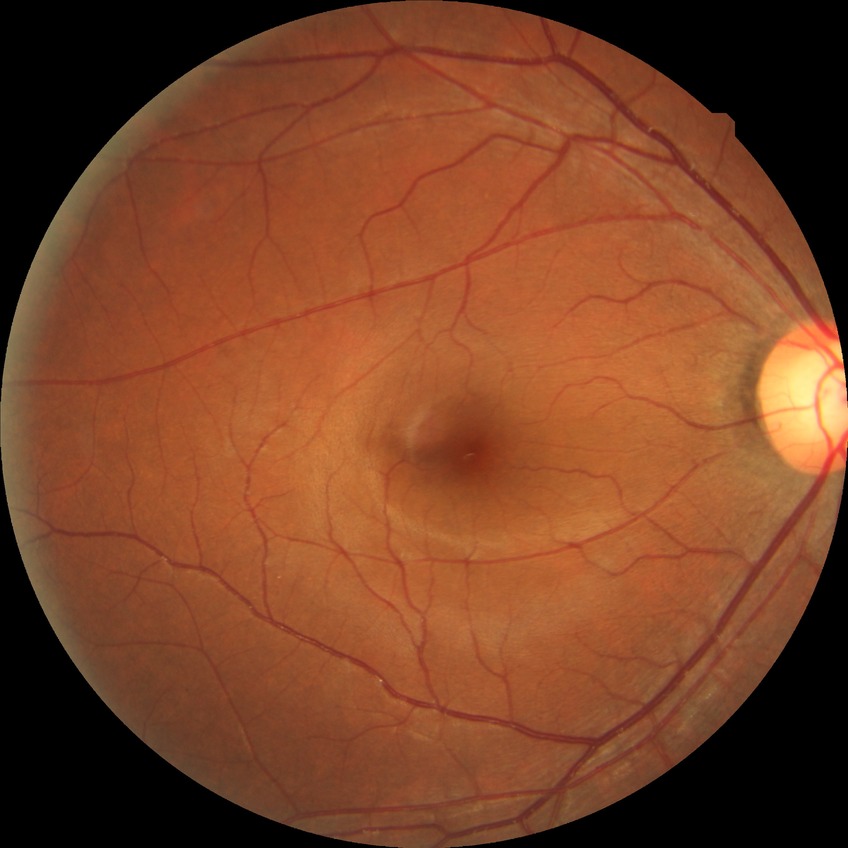

Diabetic retinopathy (DR) is NDR (no diabetic retinopathy).